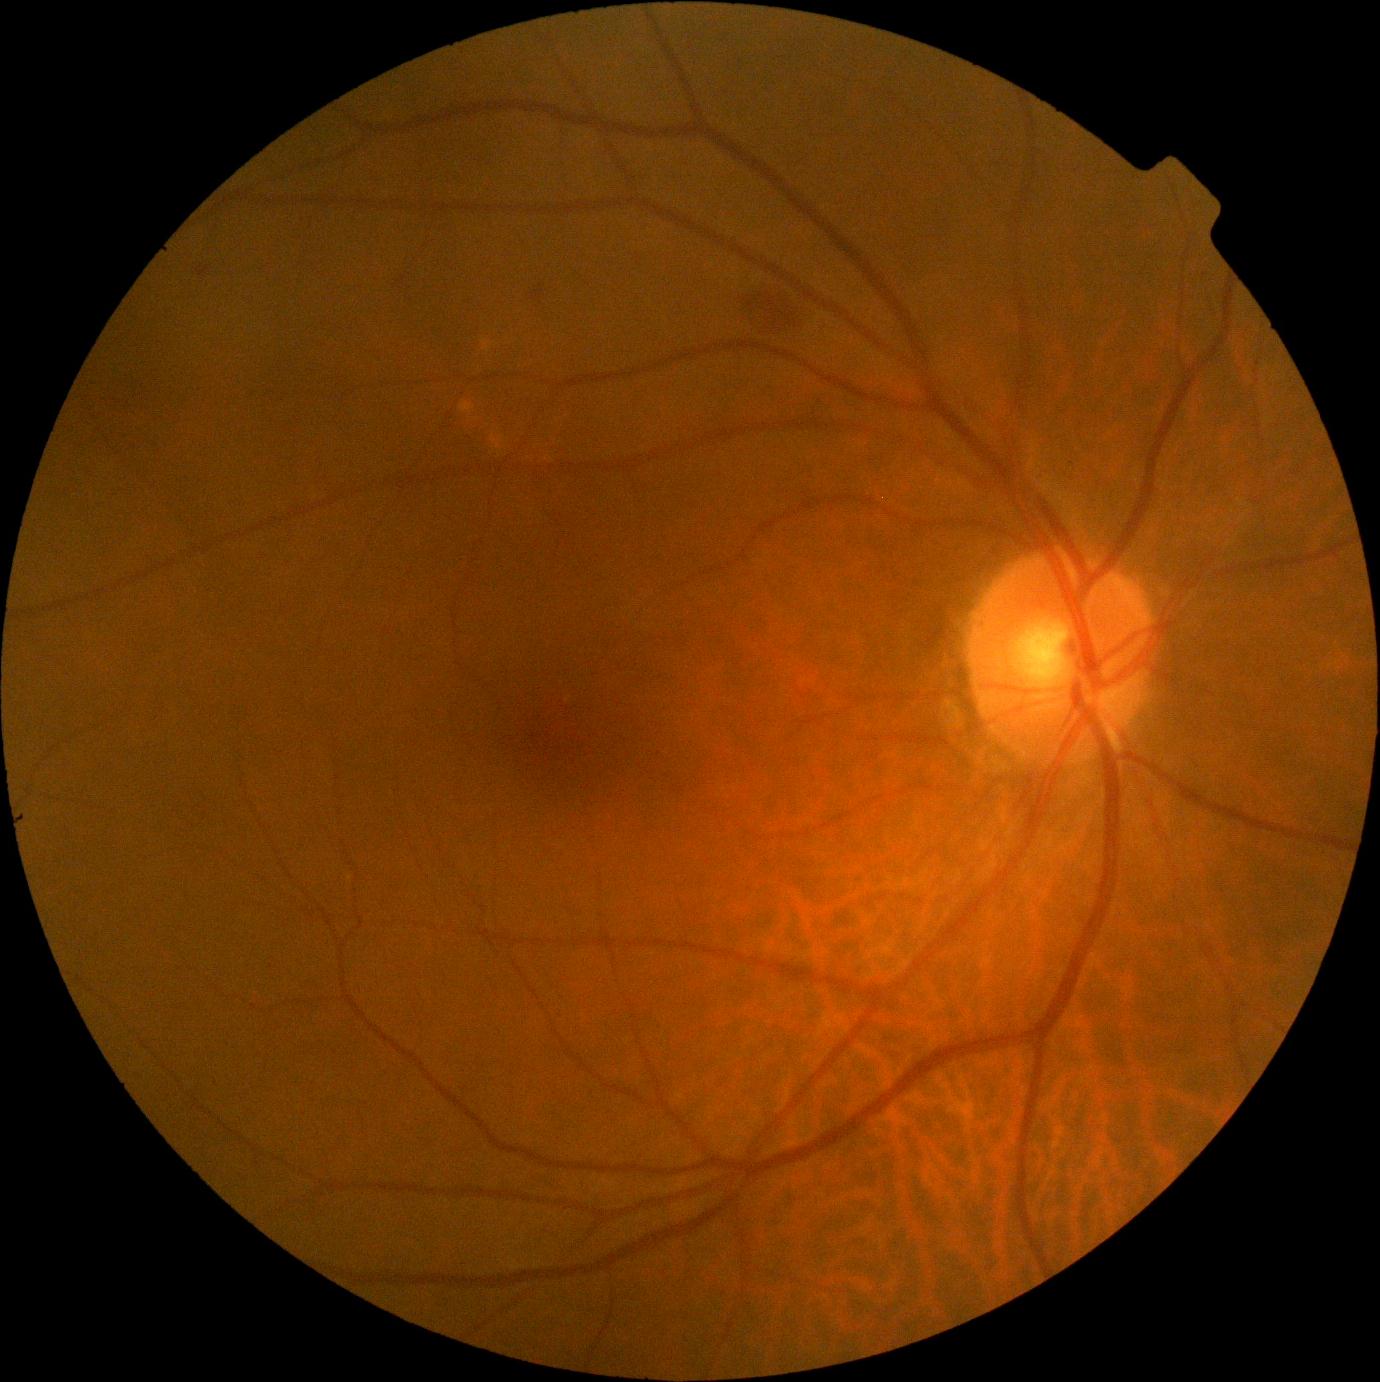
Diabetic retinopathy severity is grade 2 — more than just microaneurysms but less than severe NPDR.